Modified Davis grading.
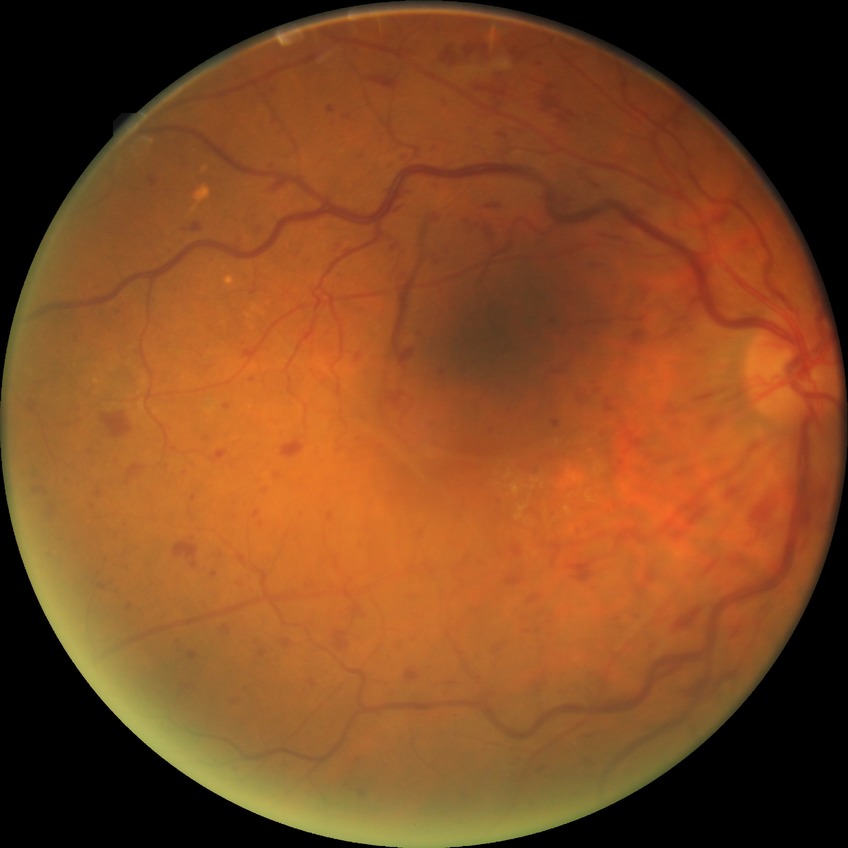

Diabetic retinopathy grade is pre-proliferative diabetic retinopathy. DR class: non-proliferative diabetic retinopathy.